Davis DR grading — 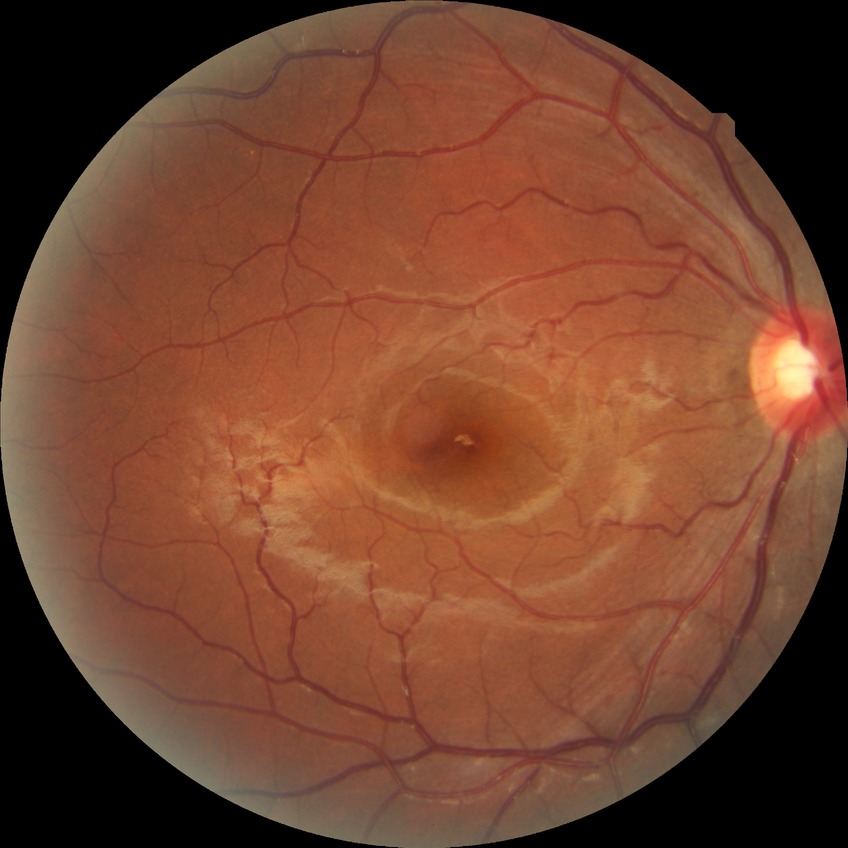 Findings:
* DR: NDR
* DR impression: negative for DR